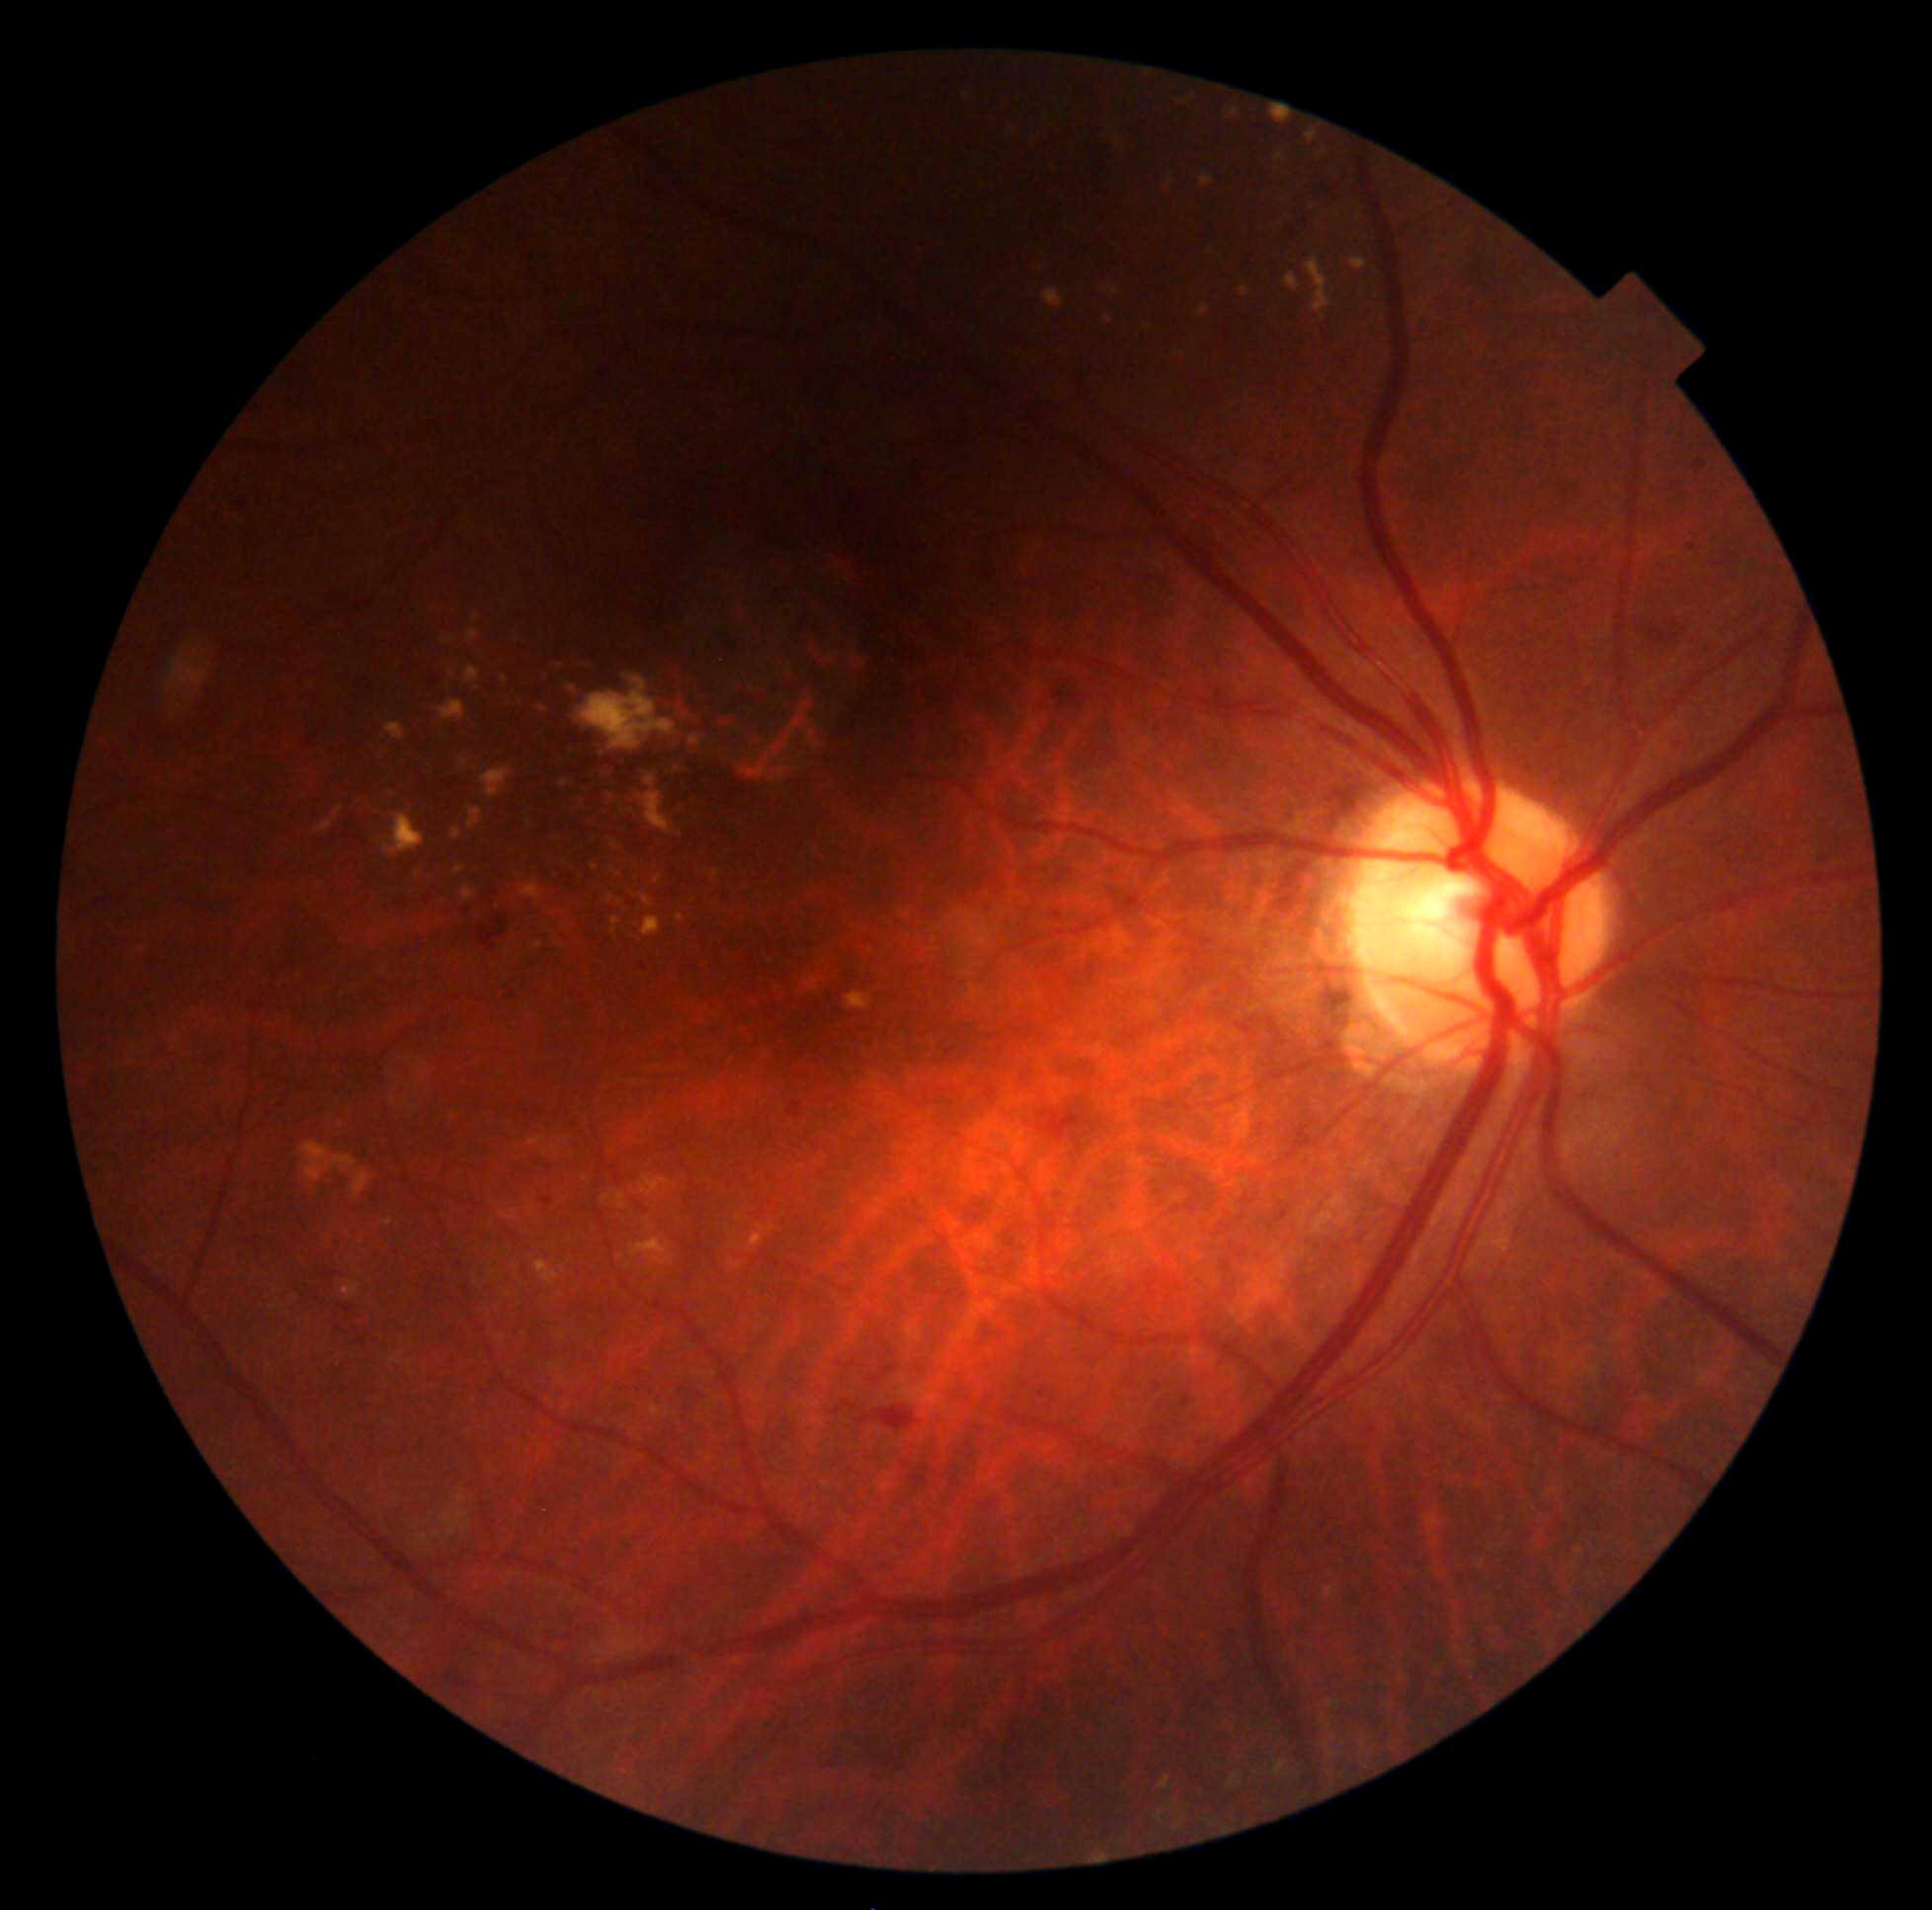 {"partial": true, "dr_grade": 2, "lesions": {"ex": [[460, 760, 469, 767], [1241, 288, 1250, 297], [385, 723, 405, 741], [317, 805, 344, 835], [1308, 257, 1332, 321], [468, 809, 482, 831], [690, 736, 701, 747], [462, 888, 475, 904], [809, 980, 818, 992], [1306, 120, 1326, 143], [611, 918, 620, 934], [537, 705, 548, 714], [534, 1261, 559, 1286], [536, 941, 543, 949]], "ex_small_approx": [[621, 1258], [621, 903], [650, 782], [682, 835], [658, 880], [753, 690]]}}